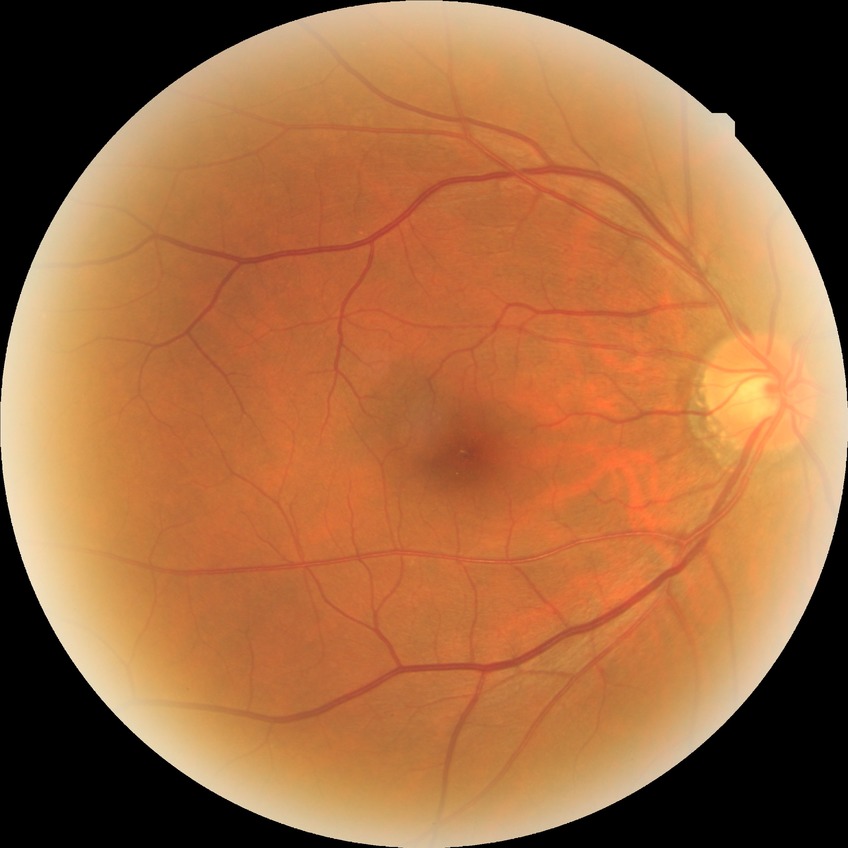 Diabetic retinopathy stage: no diabetic retinopathy.